Image size 848x848, modified Davis classification, without pupil dilation.
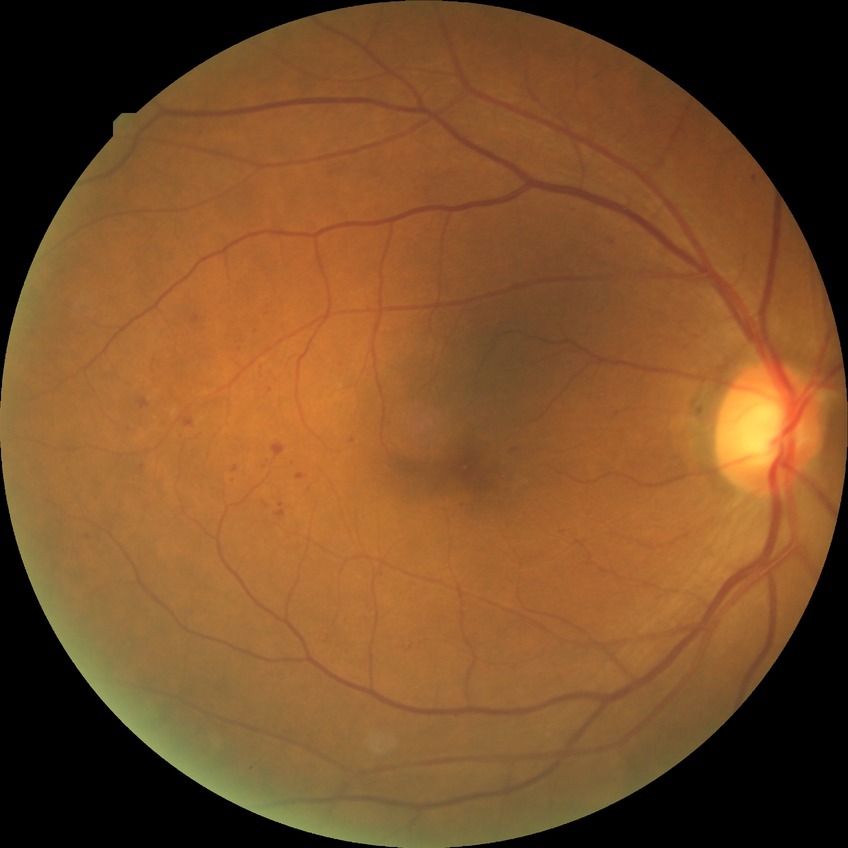

{"davis_grade": "simple diabetic retinopathy"}